Pediatric retinal photograph (wide-field) · image size 640x480 · Clarity RetCam 3, 130° FOV
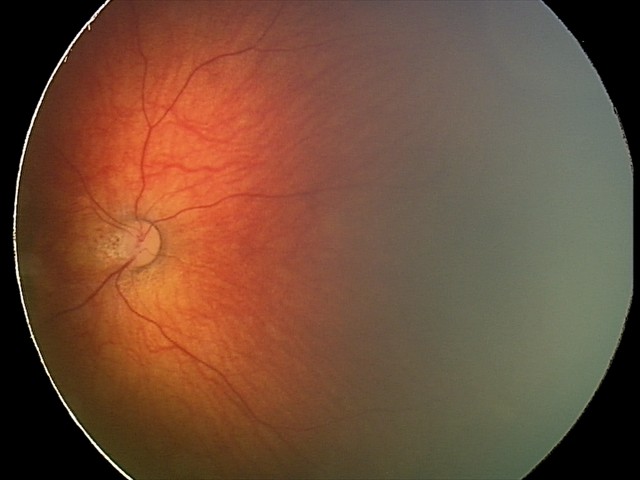
Screening examination consistent with toxoplasmosis chorioretinitis.